Nonmydriatic; 45° FOV: 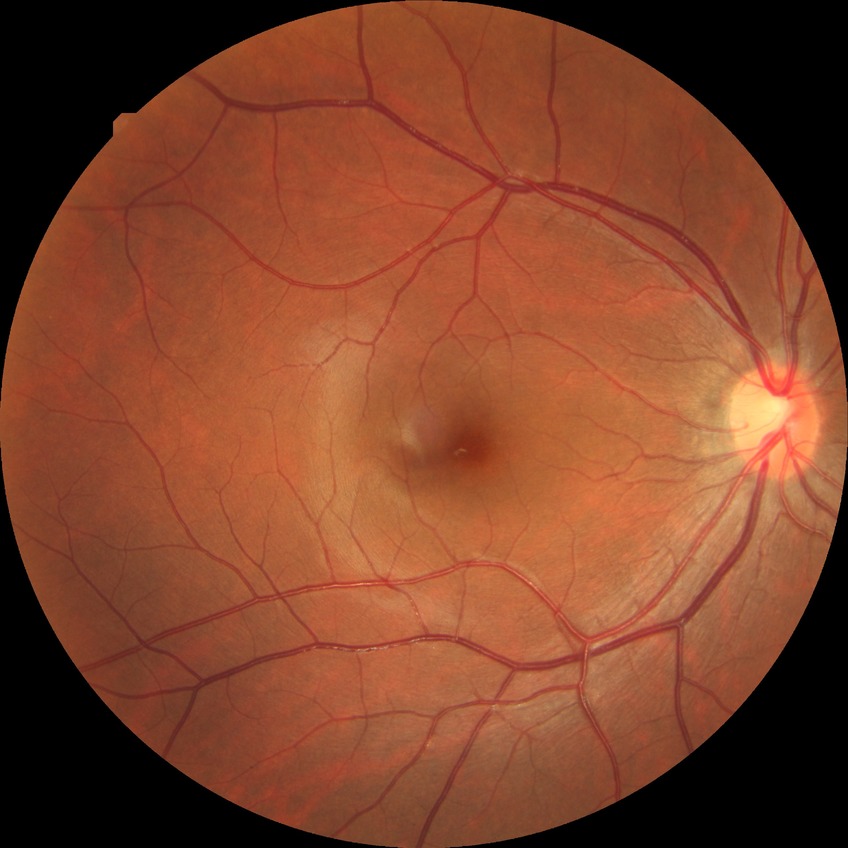 DR grade: NDR.